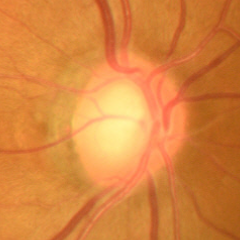 The image shows no signs of glaucoma.